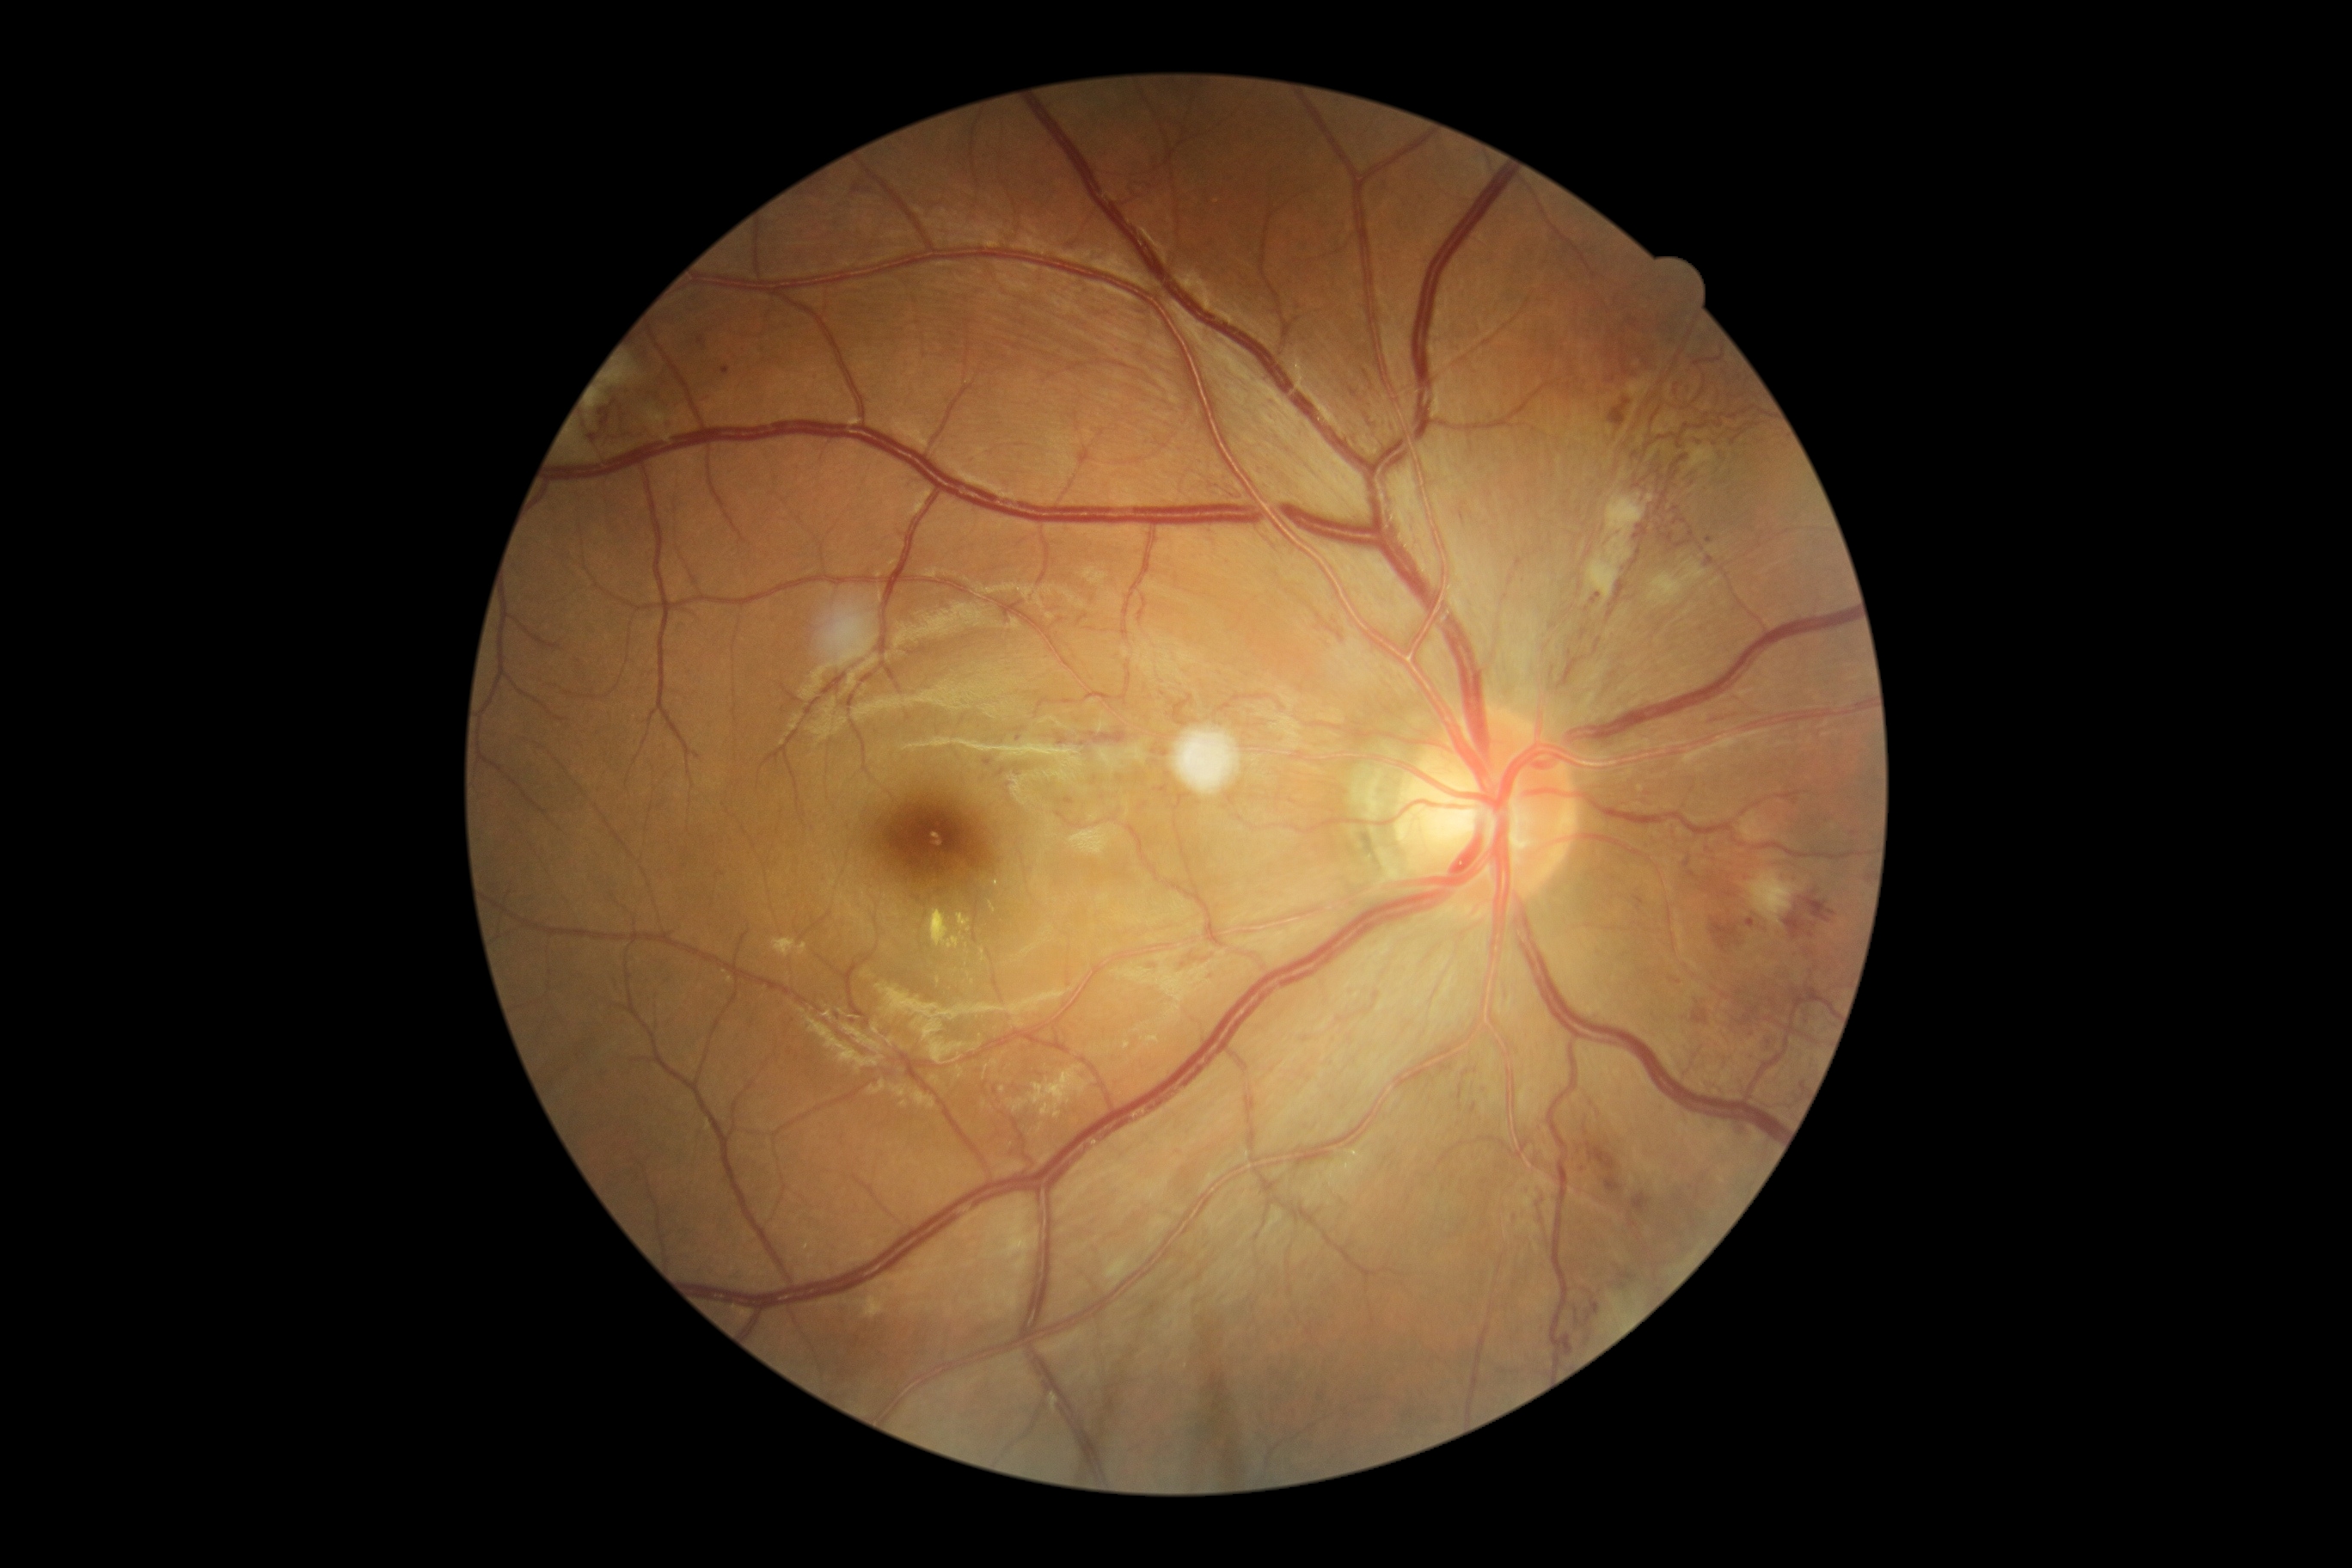 DR grade: 4 (PDR).
HEs are present, including at x1=1560 y1=1333 x2=1572 y2=1357; x1=1087 y1=732 x2=1127 y2=744; x1=1057 y1=797 x2=1075 y2=805; x1=1737 y1=1124 x2=1753 y2=1137; x1=1705 y1=709 x2=1746 y2=726; x1=1574 y1=1297 x2=1602 y2=1328; x1=1748 y1=919 x2=1755 y2=928; x1=1608 y1=376 x2=1617 y2=384; x1=1620 y1=353 x2=1631 y2=377; x1=1173 y1=953 x2=1213 y2=971; x1=1471 y1=1103 x2=1478 y2=1115; x1=1799 y1=890 x2=1837 y2=924; x1=1144 y1=962 x2=1158 y2=967; x1=1055 y1=733 x2=1069 y2=745; x1=1619 y1=1271 x2=1638 y2=1290; x1=1591 y1=594 x2=1602 y2=604.
HEs (small, approximate centers) near (1467, 1073); (1460, 1107).